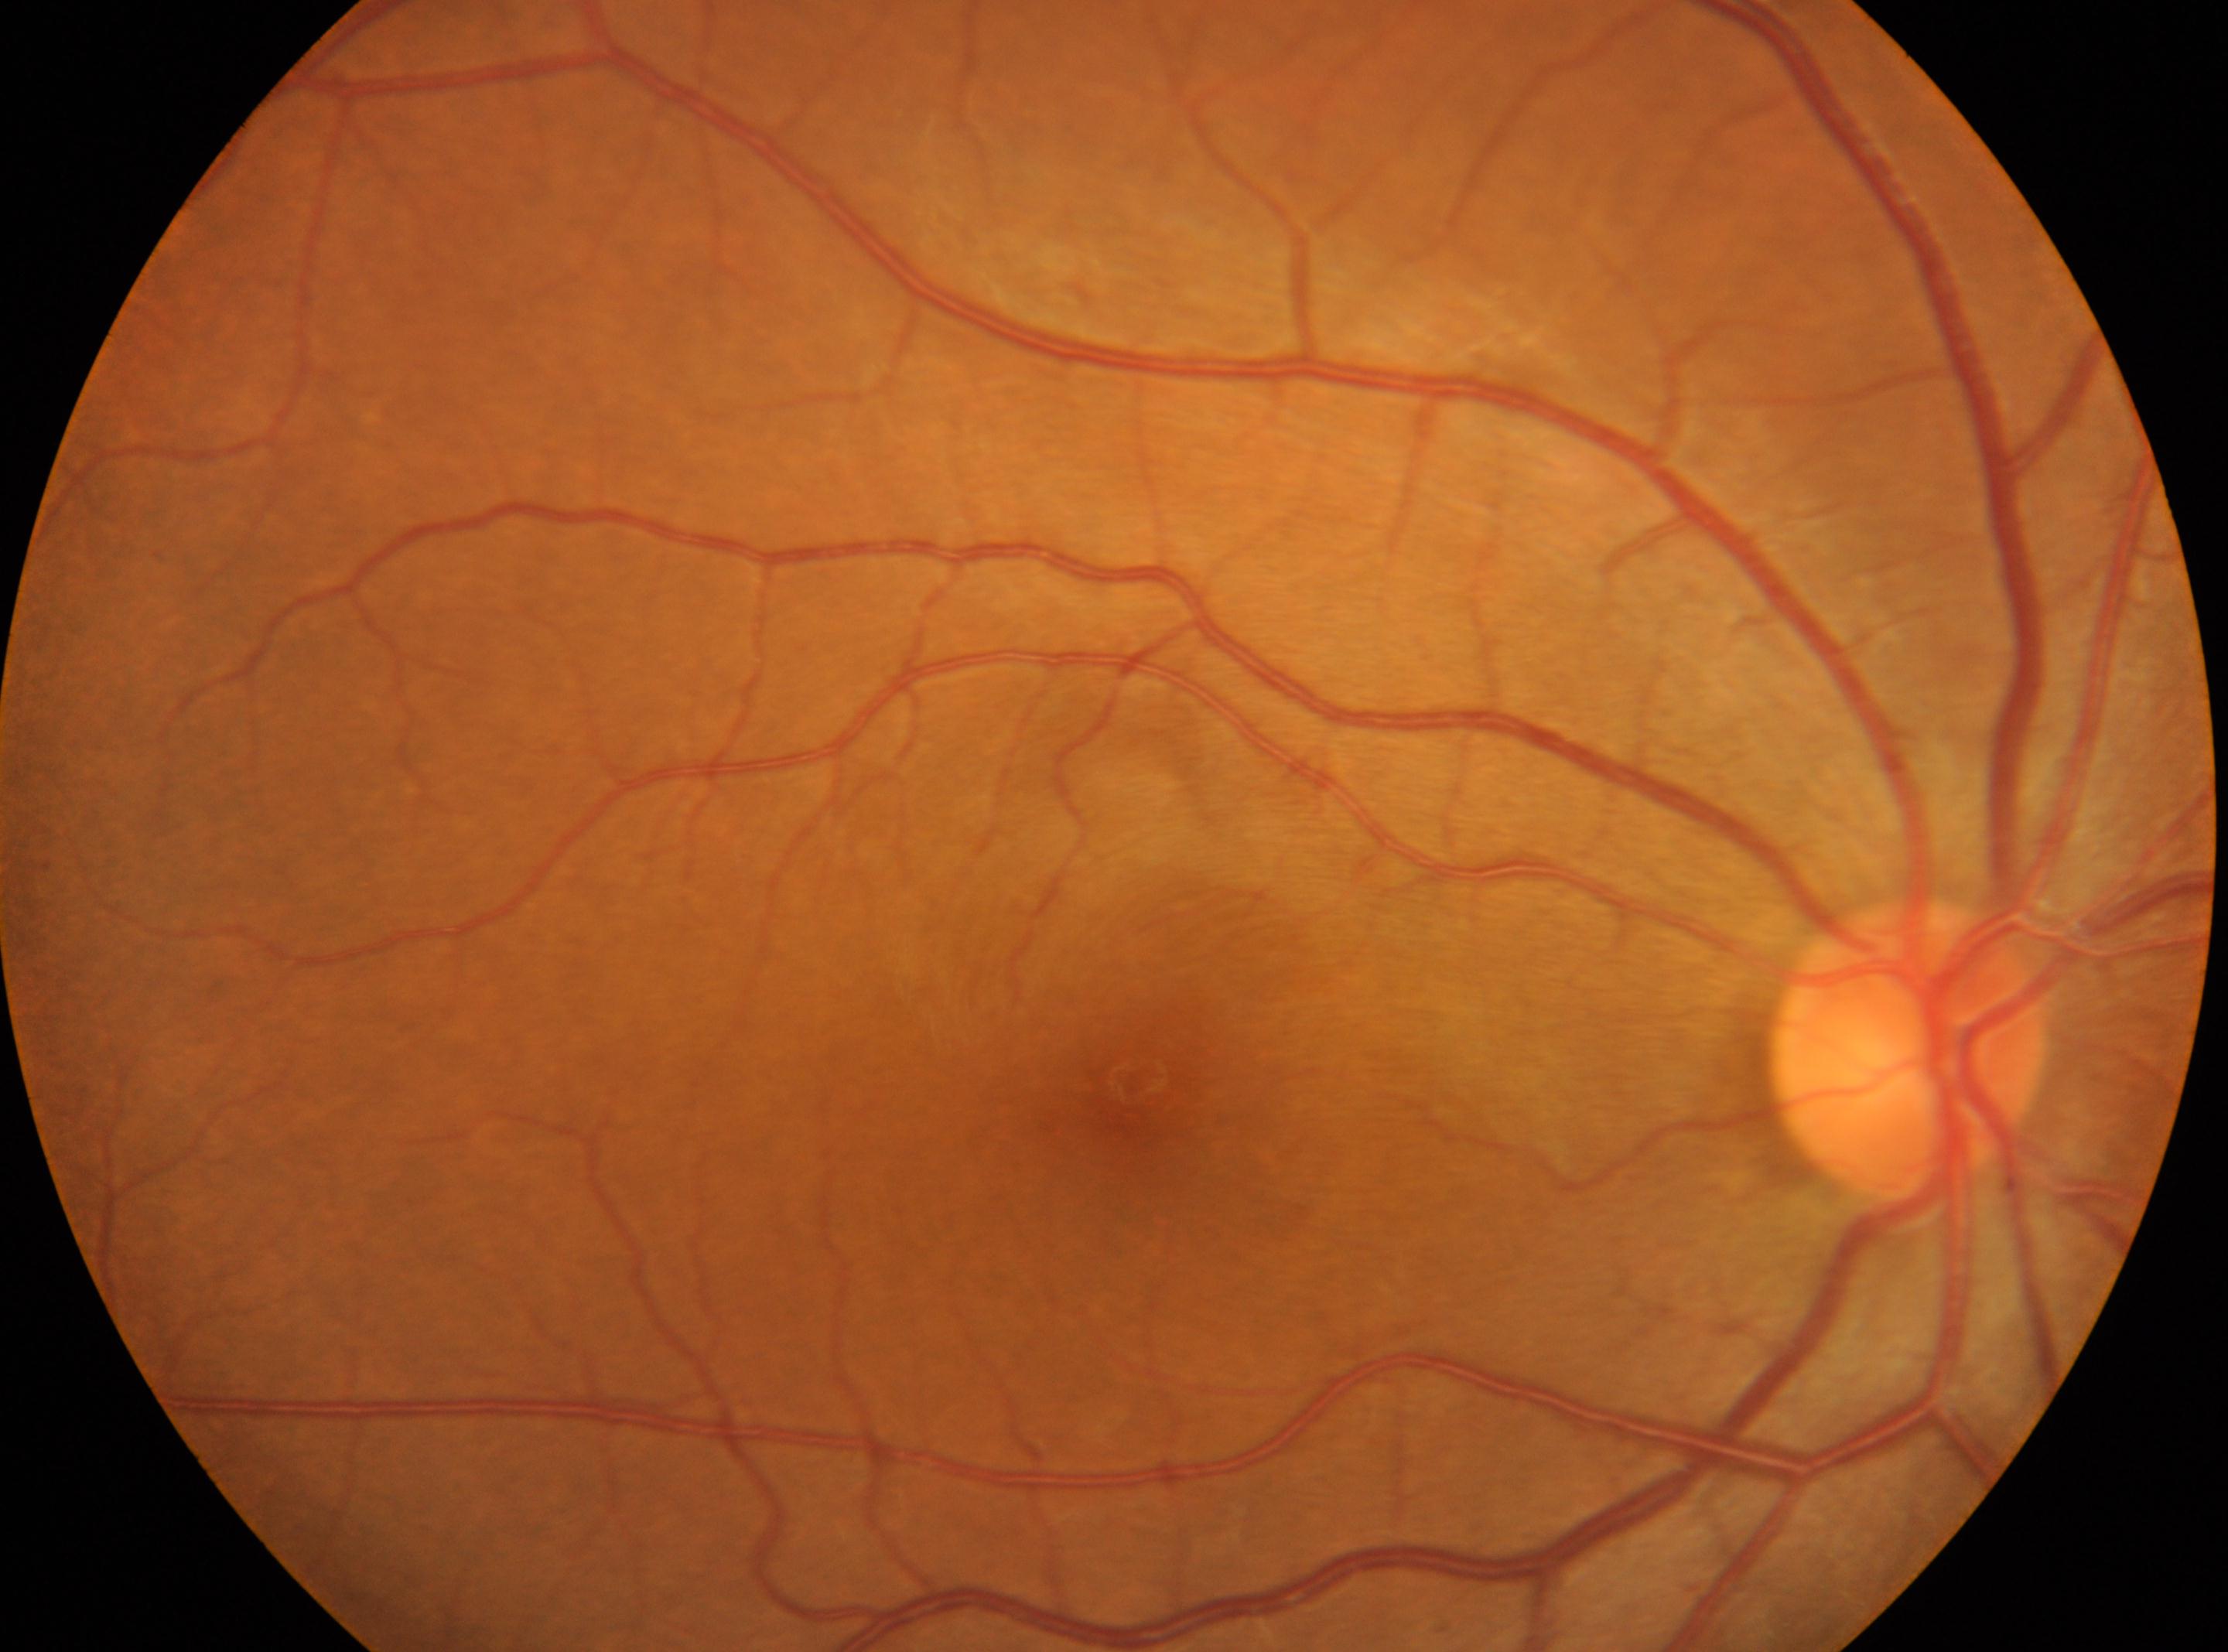

Annotations:
• laterality — right eye
• DR — 0/4 — no visible signs of diabetic retinopathy
• fovea center — 1133px, 1080px
• optic disc — 1906px, 1051px